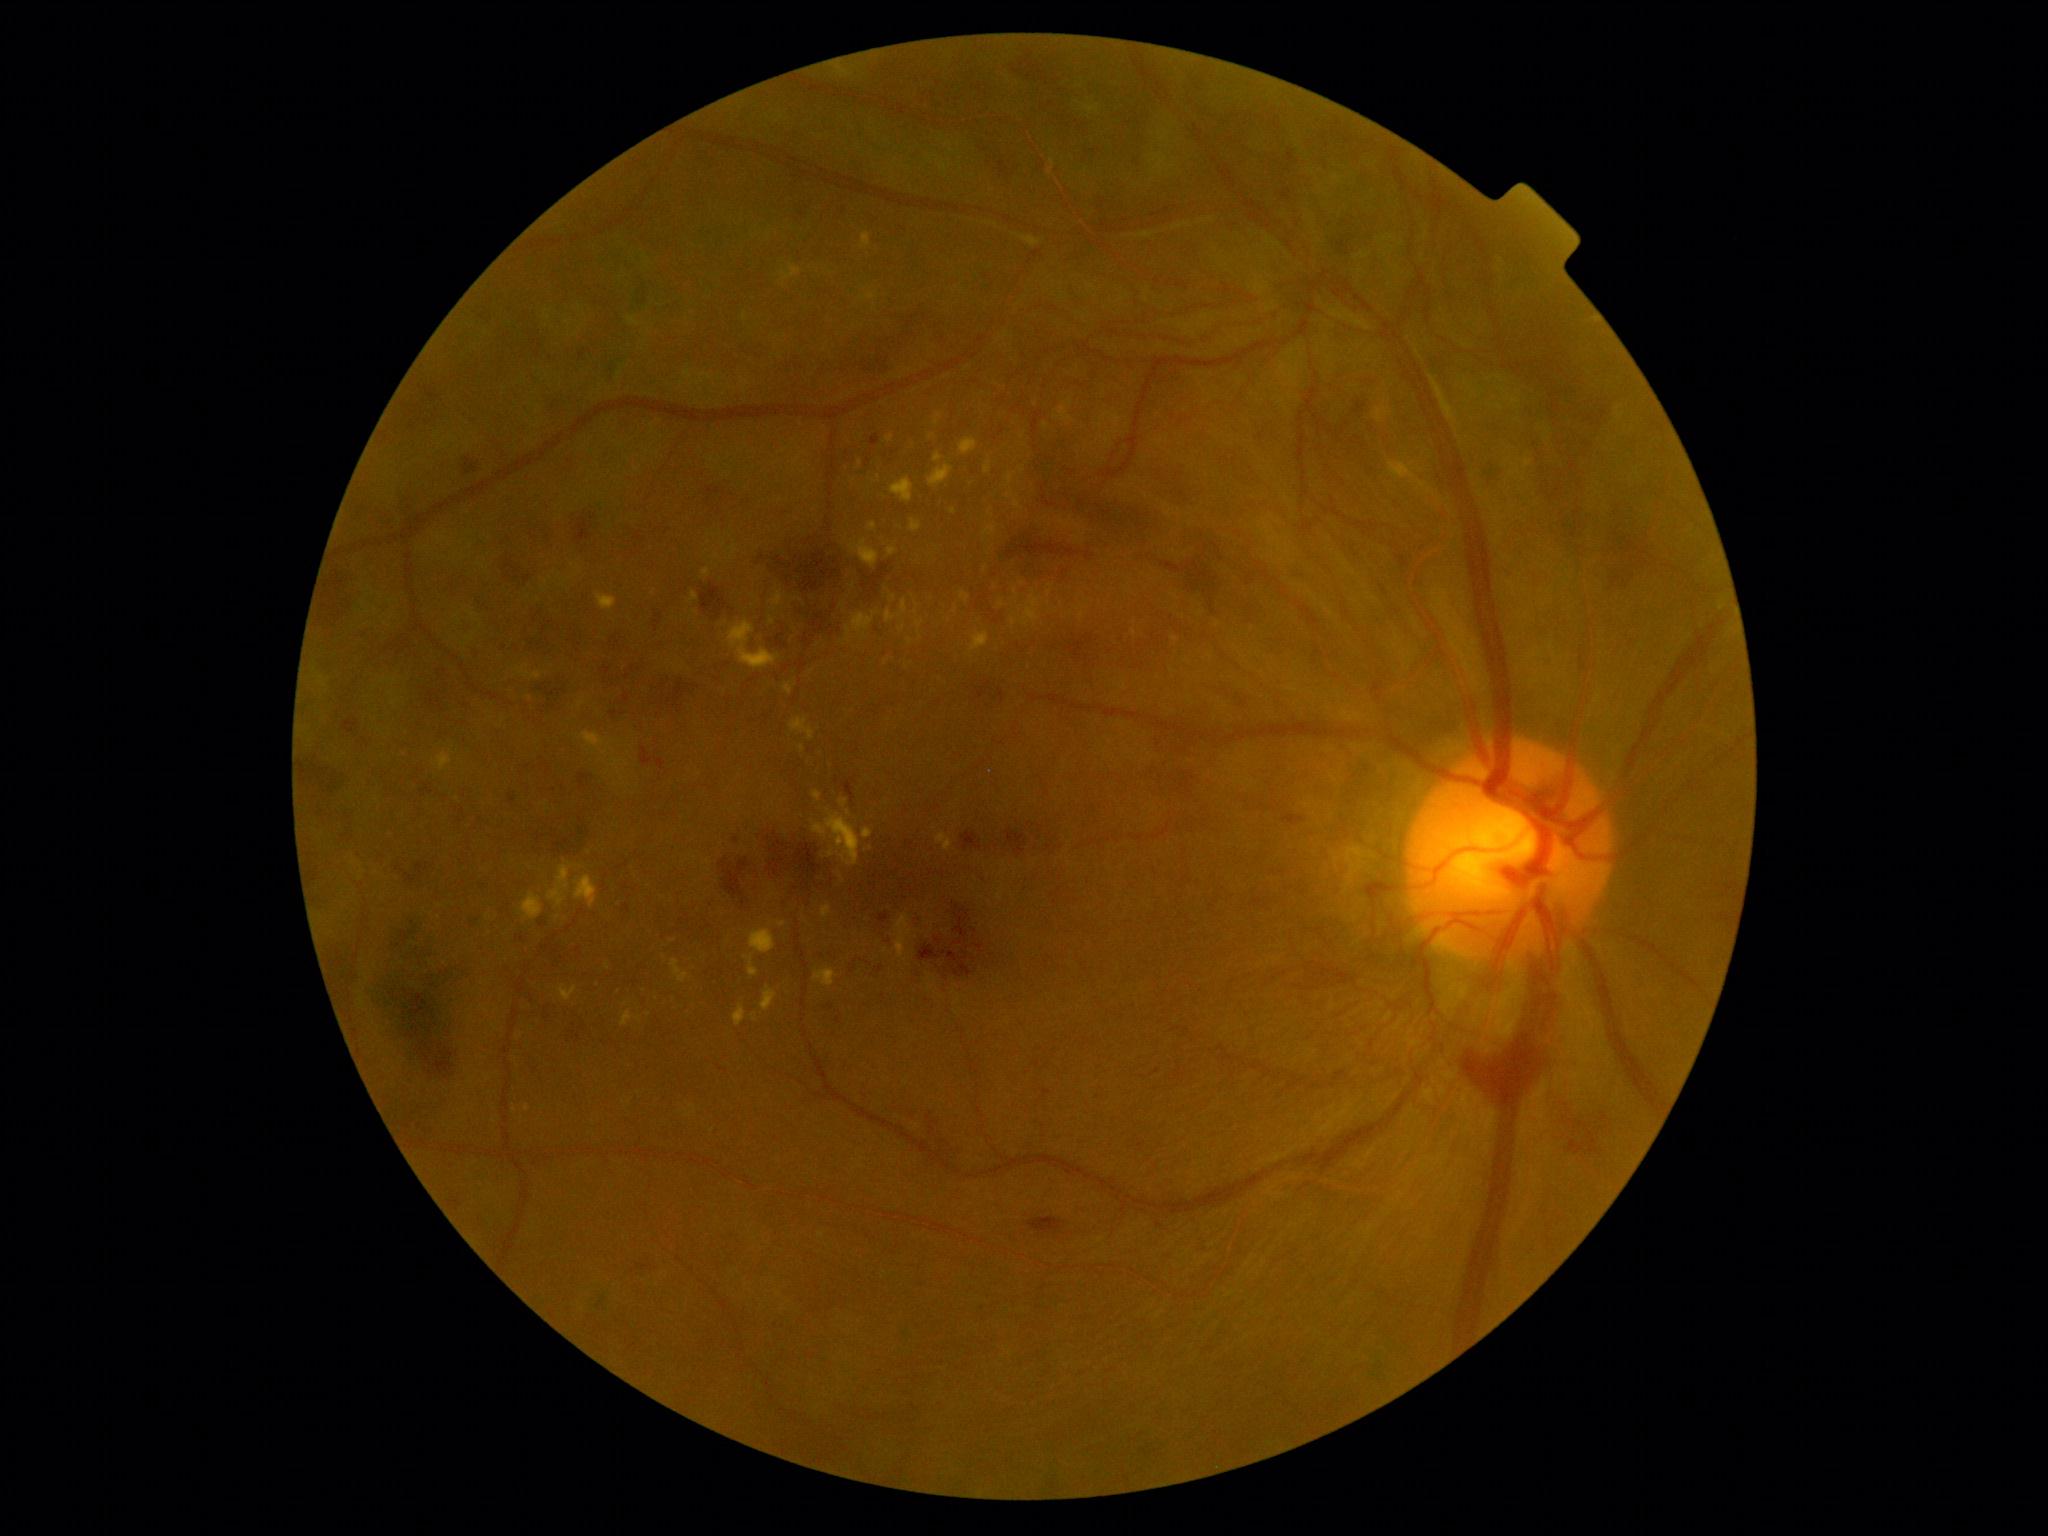

Diabetic retinopathy (DR) is 4
A subset of detected lesions:
hard exudates (EXs) (continued): {"x1": 1068, "y1": 399, "x2": 1074, "y2": 407} | {"x1": 770, "y1": 617, "x2": 776, "y2": 626} | {"x1": 846, "y1": 610, "x2": 879, "y2": 644} | {"x1": 522, "y1": 892, "x2": 544, "y2": 921} | {"x1": 1101, "y1": 430, "x2": 1120, "y2": 444} | {"x1": 784, "y1": 683, "x2": 793, "y2": 695} | {"x1": 822, "y1": 905, "x2": 832, "y2": 918} | {"x1": 813, "y1": 968, "x2": 837, "y2": 987} | {"x1": 777, "y1": 921, "x2": 787, "y2": 928} | {"x1": 862, "y1": 233, "x2": 872, "y2": 249} | {"x1": 435, "y1": 753, "x2": 453, "y2": 772} | {"x1": 1007, "y1": 474, "x2": 1014, "y2": 488}
Small EXs near (990, 511) | (953, 511) | (626, 1004) | (1100, 426) | (910, 642) | (724, 545) | (1202, 613) | (514, 1110)